Ultra-widefield fundus mosaic: 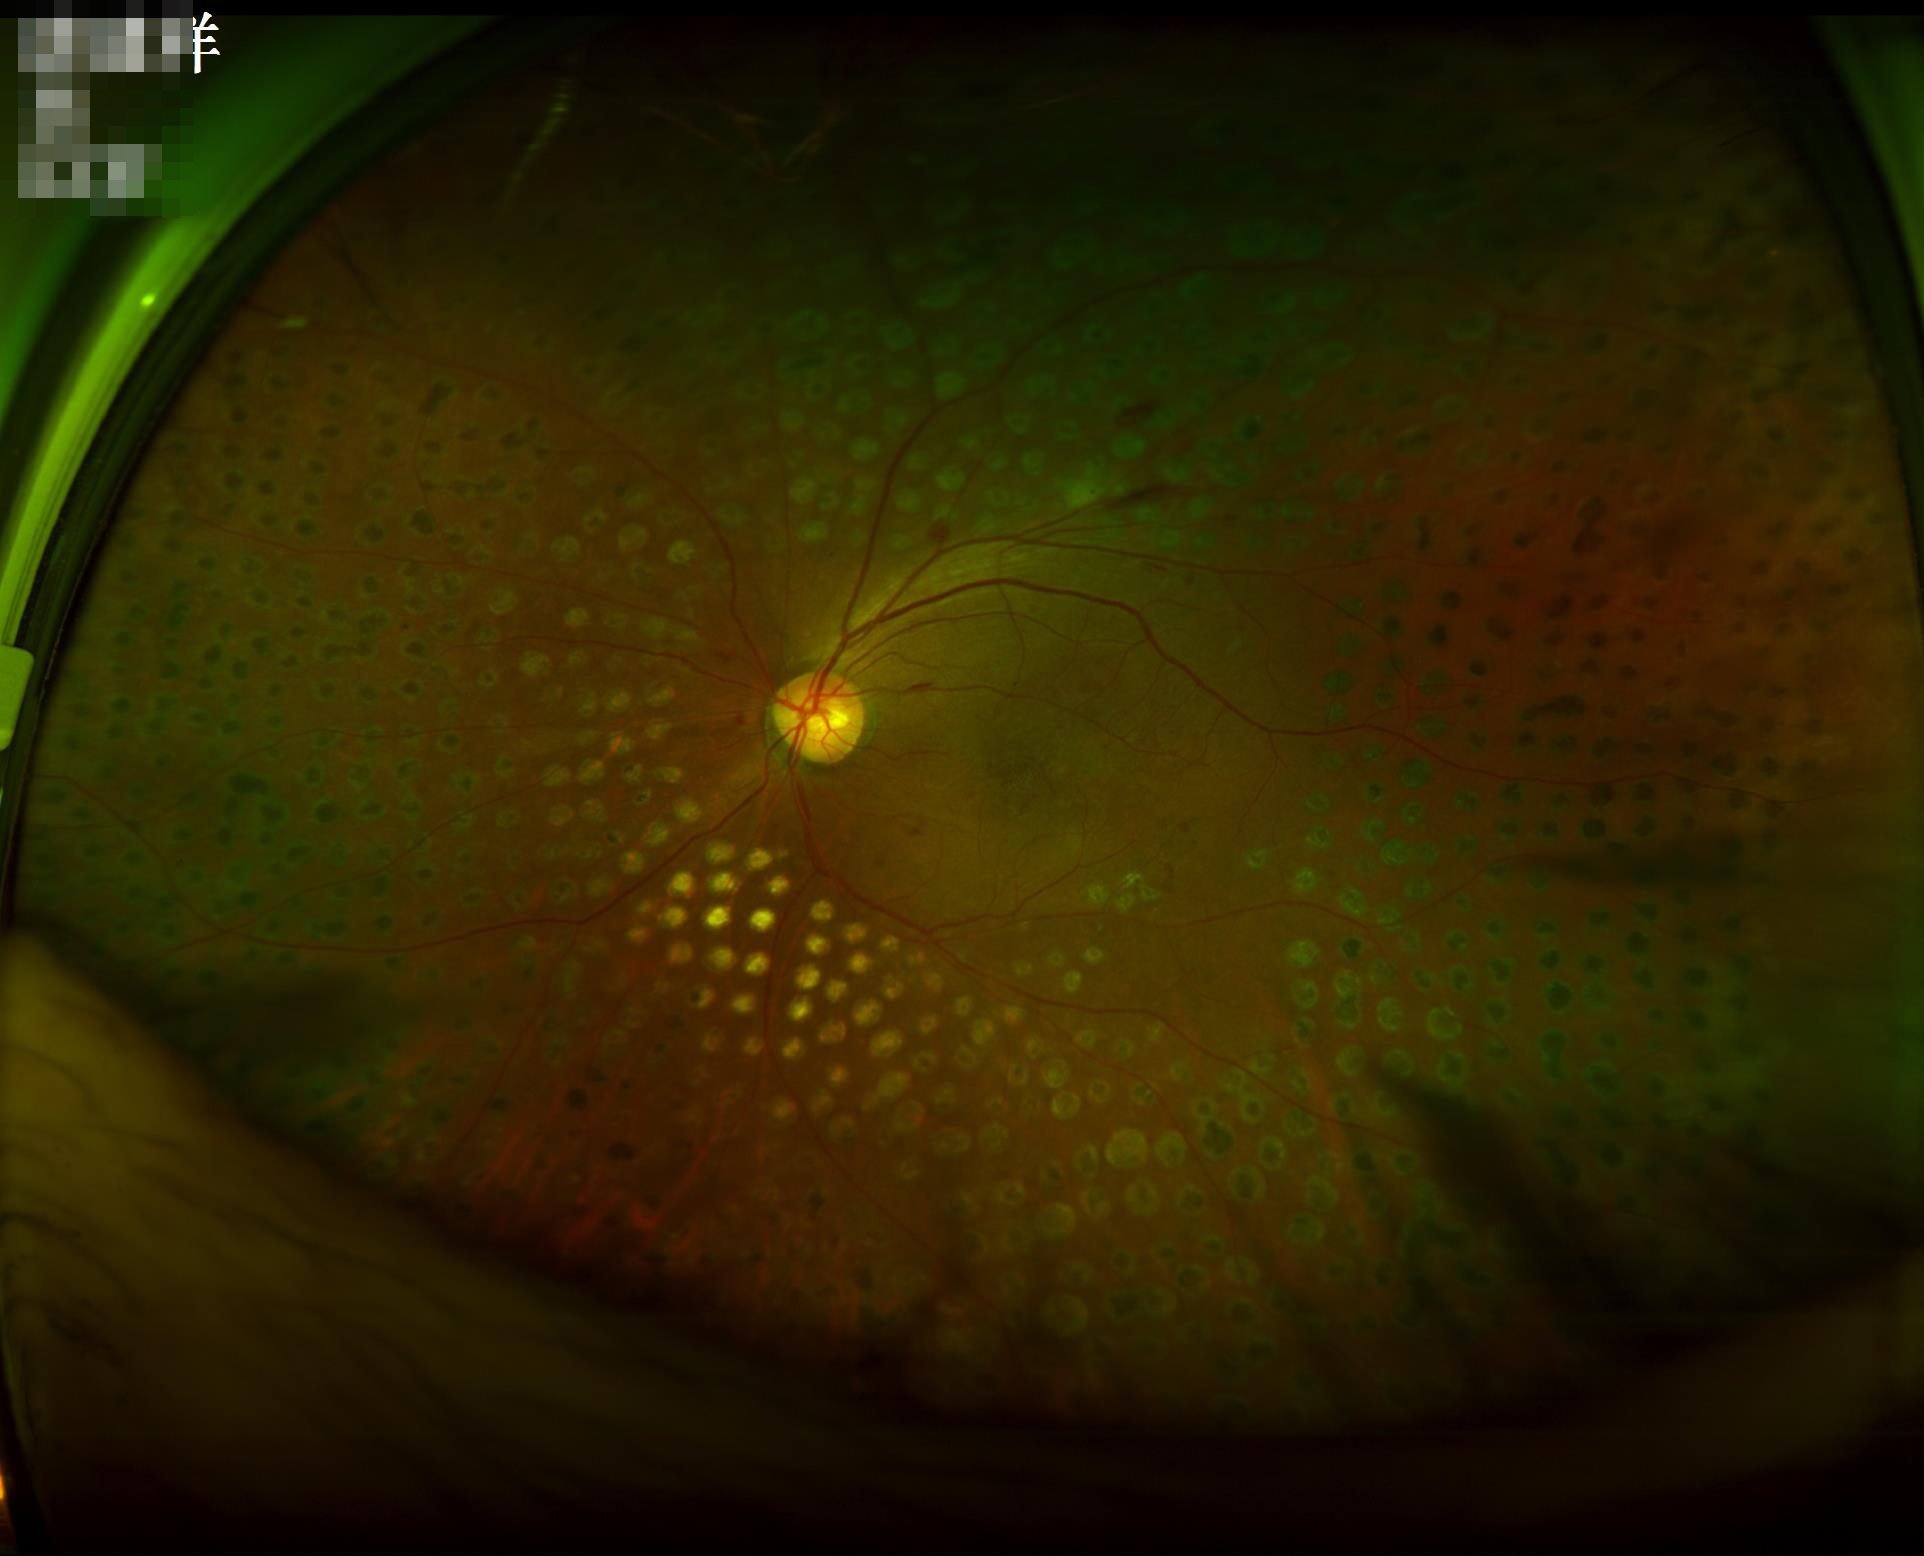 Image is sharp throughout the field.
There is over- or under-exposure or a color cast.